2361 by 1568 pixels, tabletop color fundus camera image — 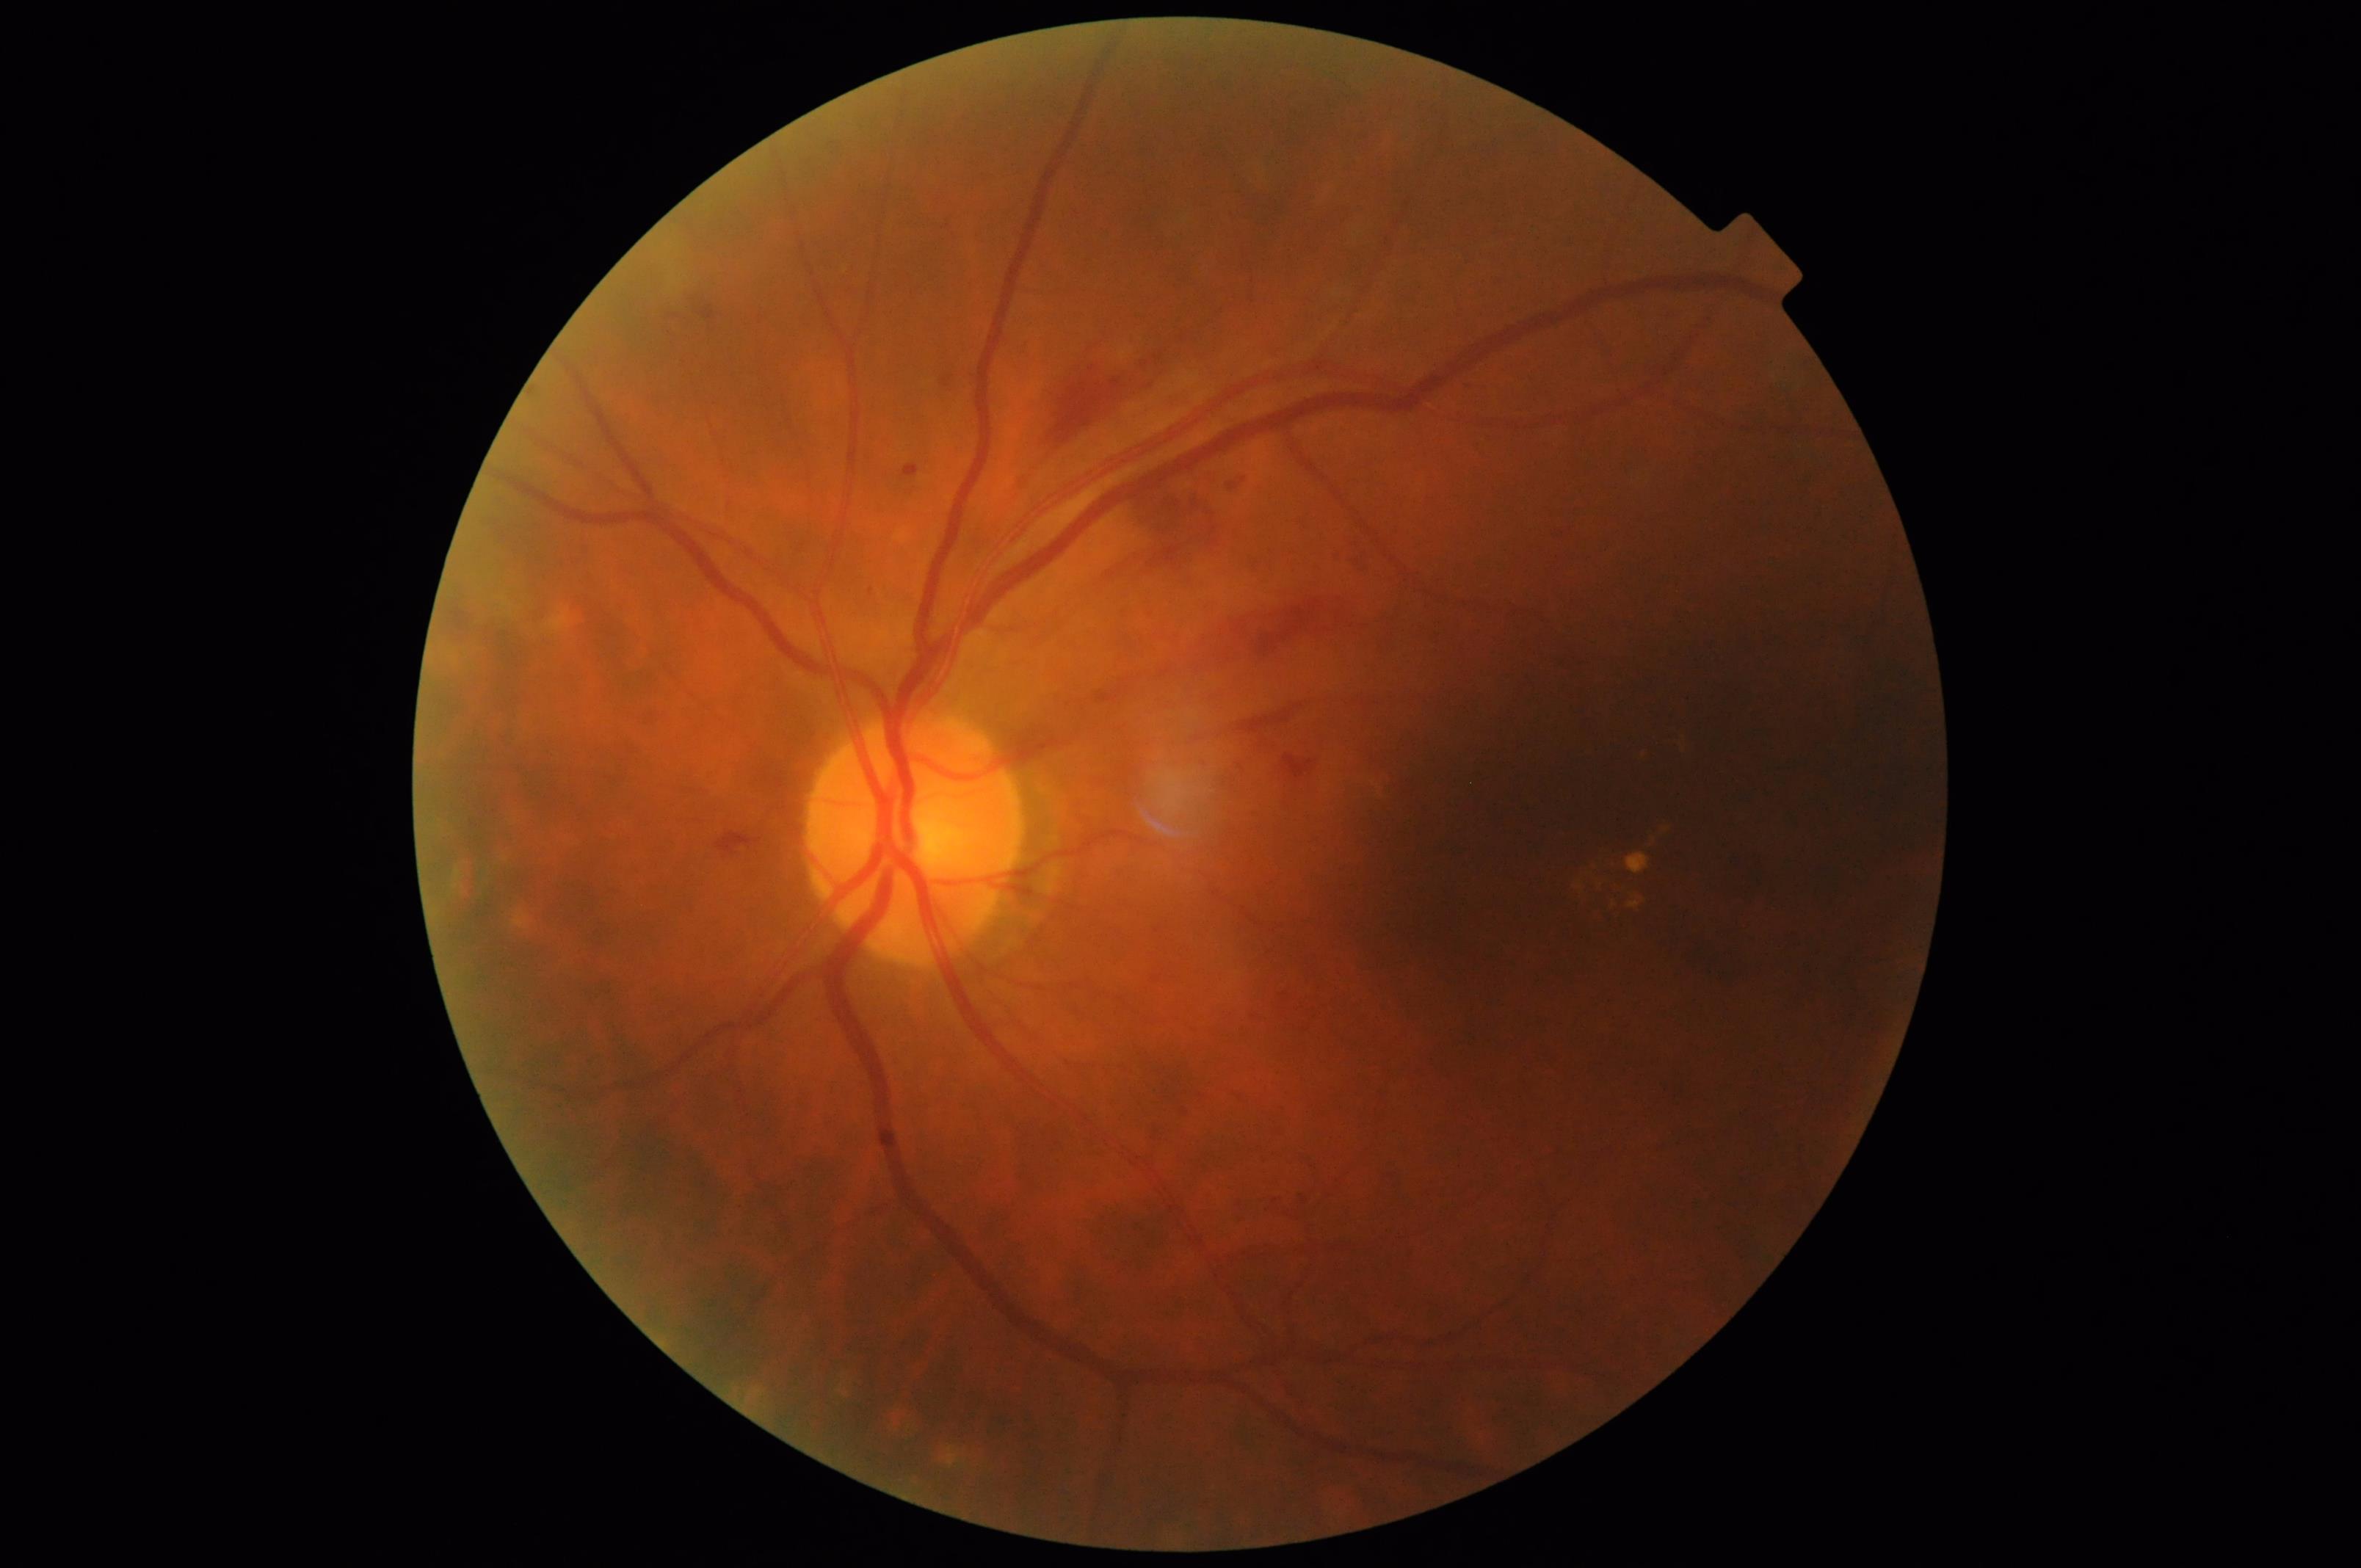 {"overall_quality": "acceptable", "illumination": "poor"}